1525x1280px:
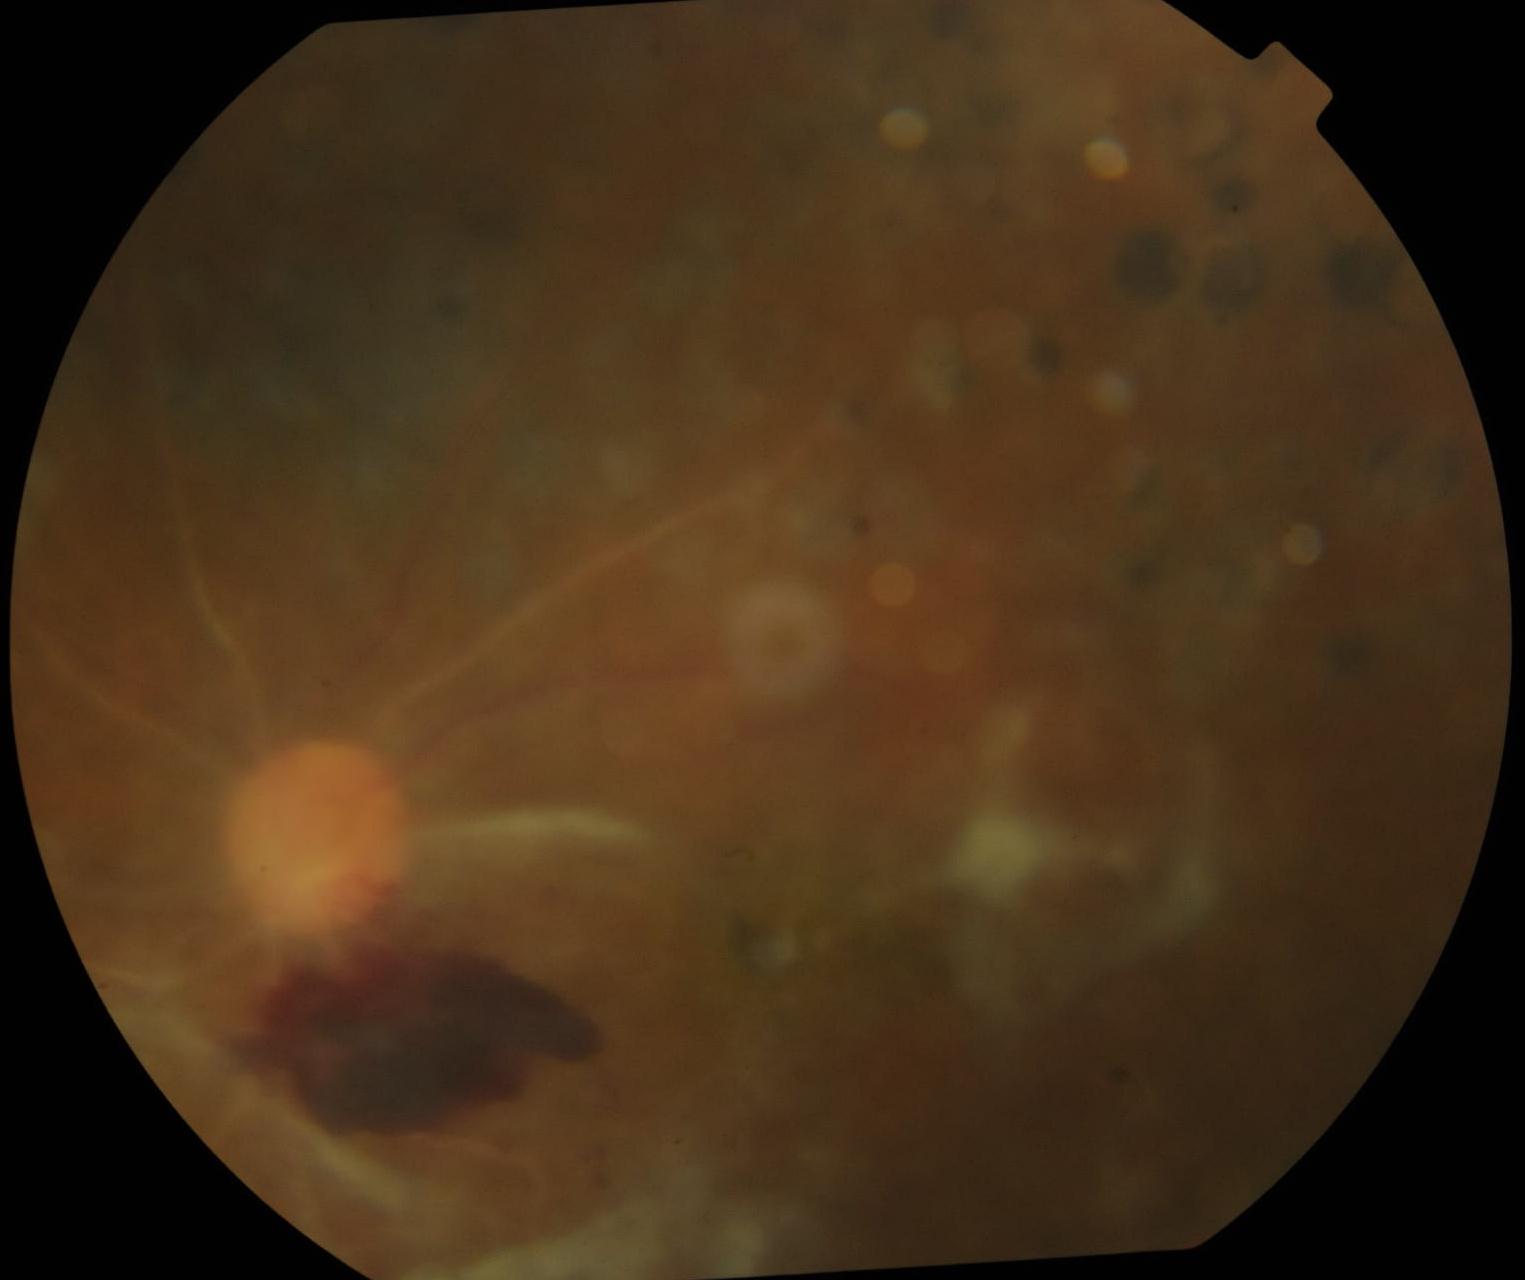
DR stage: grade 4 (PDR).